Pediatric retinal photograph (wide-field); camera: Clarity RetCam 3 (130° FOV) — 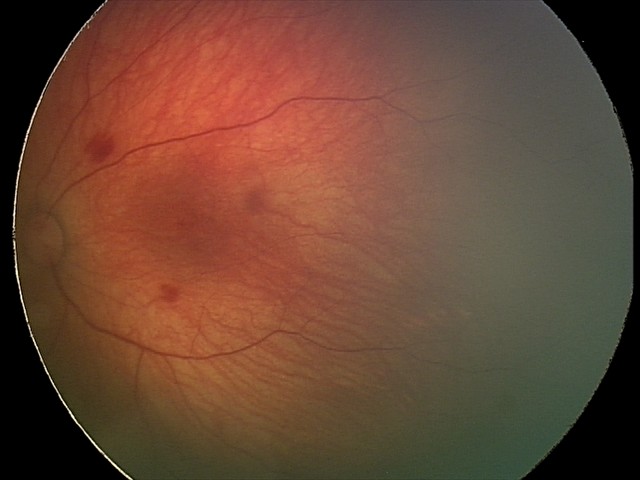

Screening series with retinal hemorrhages.